1659x2212, acquired with a Remidio FOP fundus camera
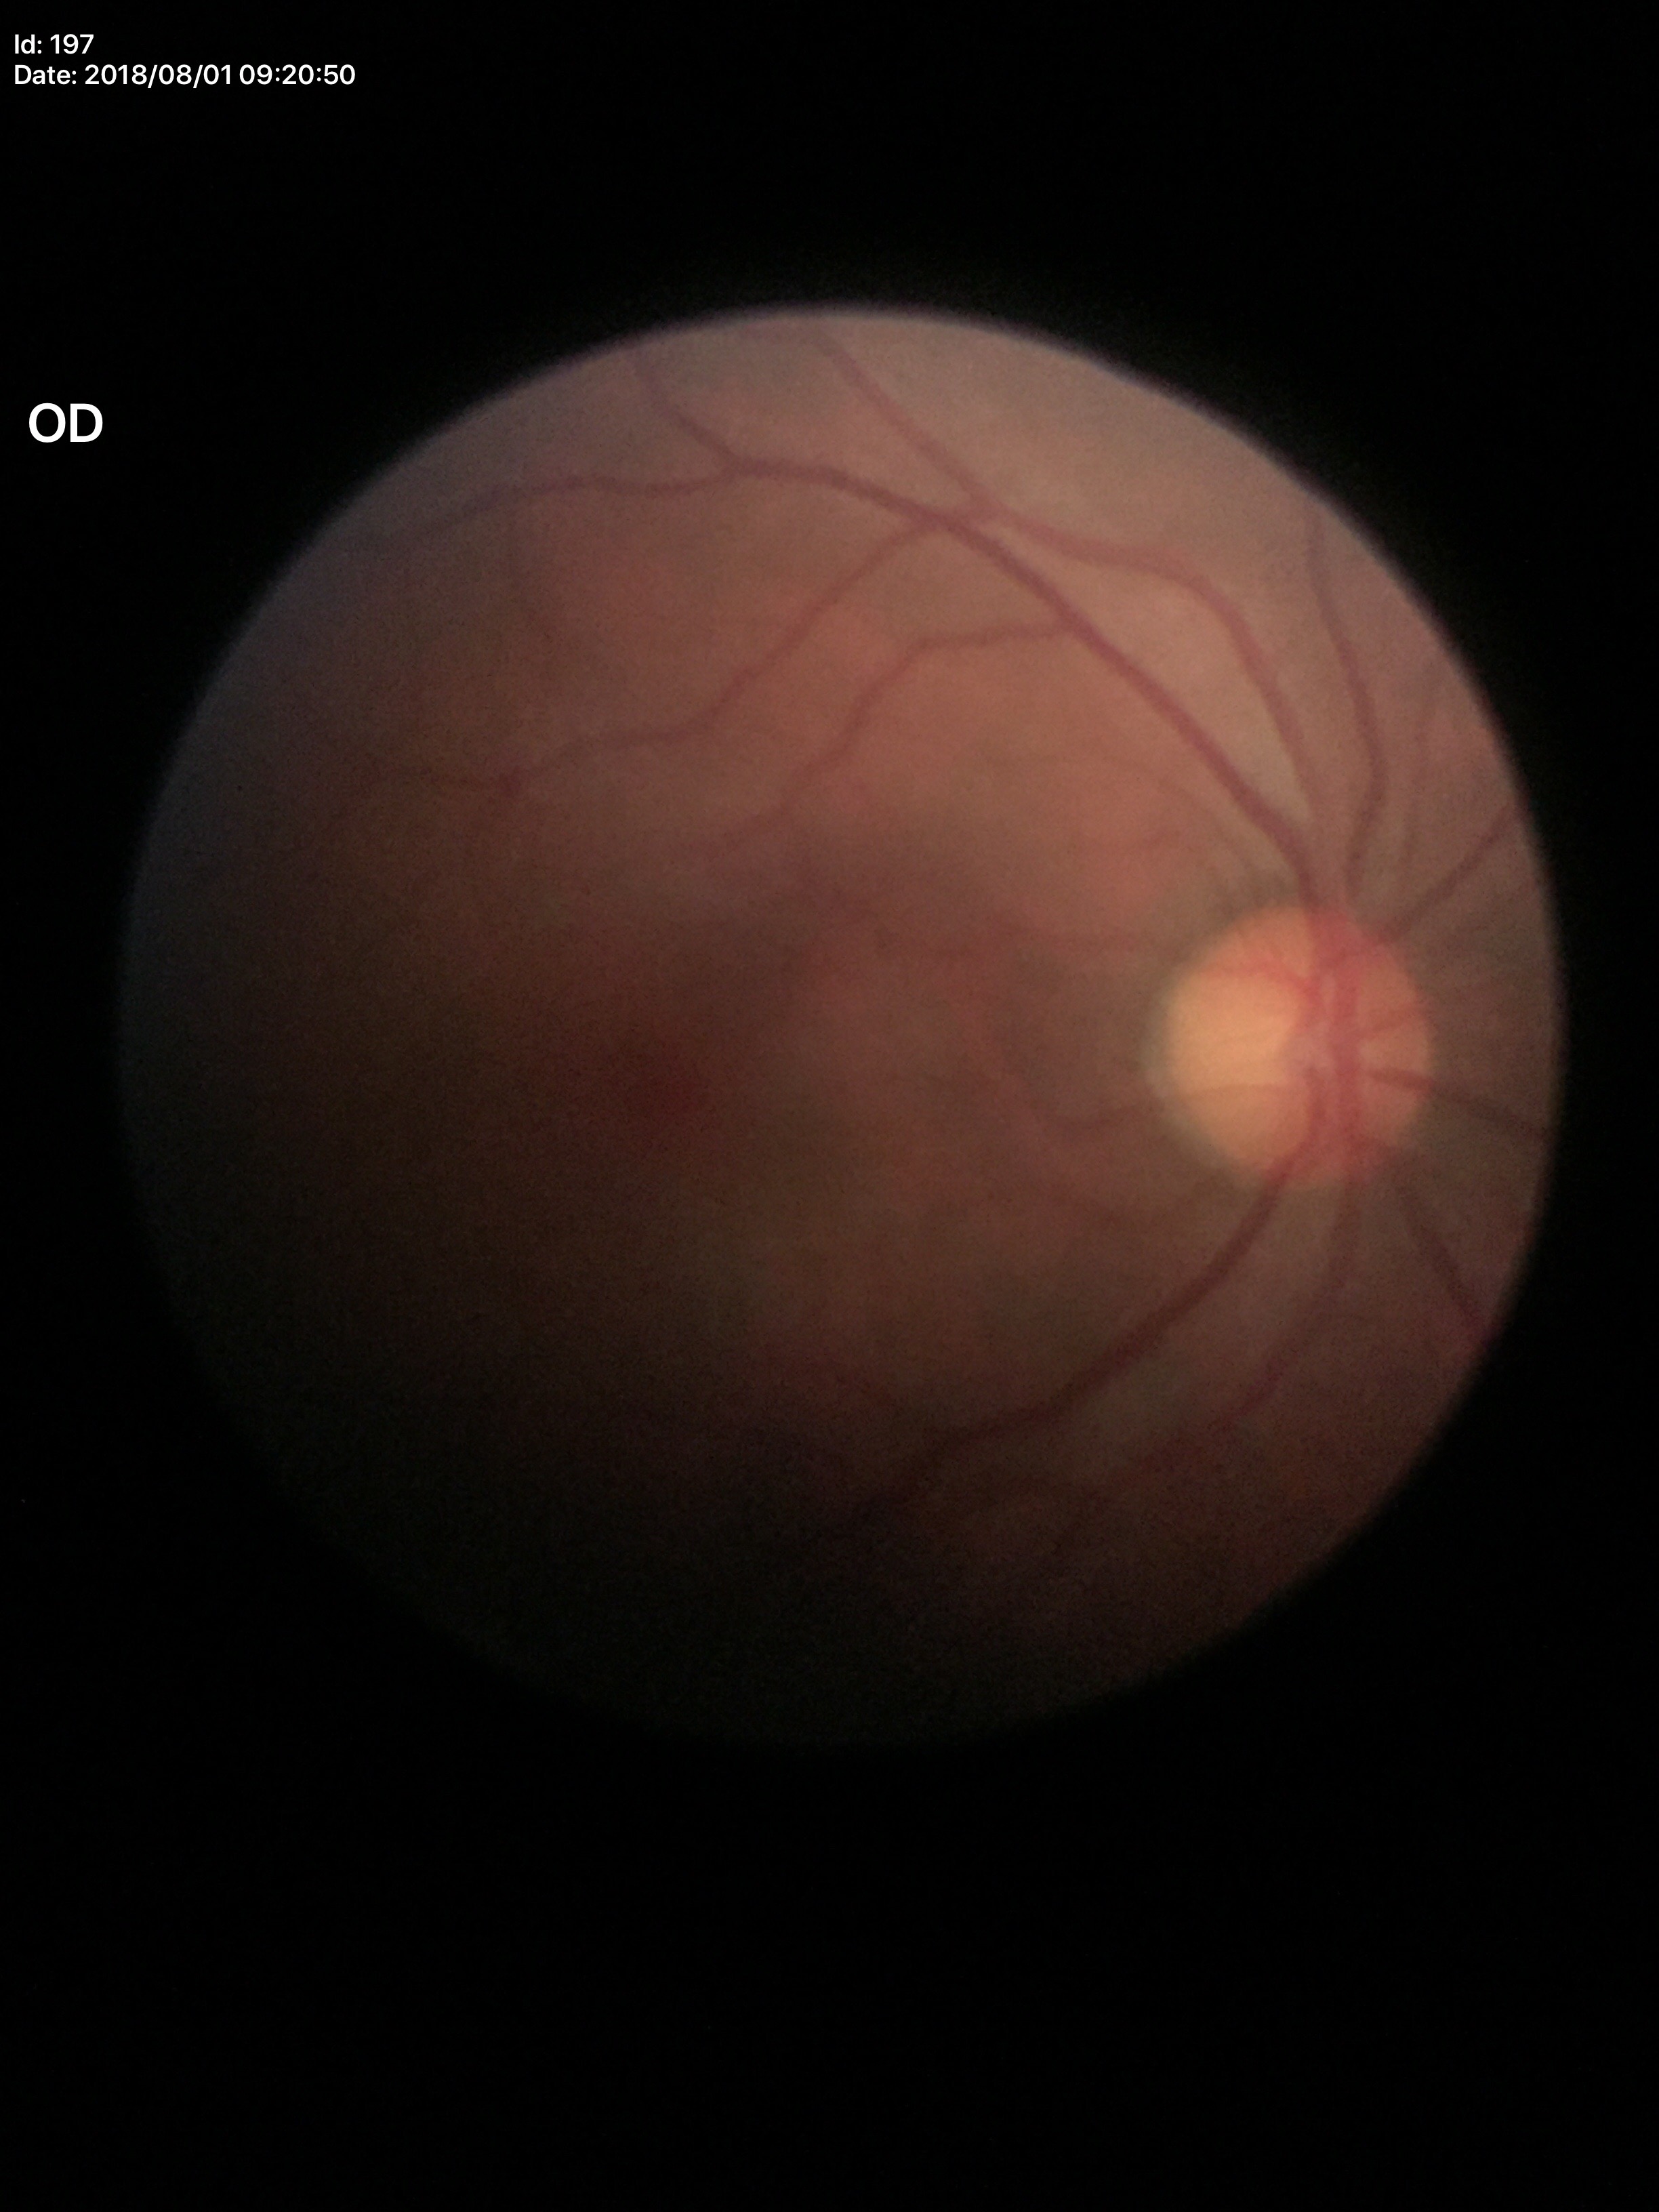

Q: What is the HCDR?
A: 0.48
Q: Glaucoma screening result?
A: negative
Q: What is the vertical cup-to-disc ratio?
A: 0.44
Q: What is the area cup-to-disc ratio?
A: 0.21